45° field of view, CFP:
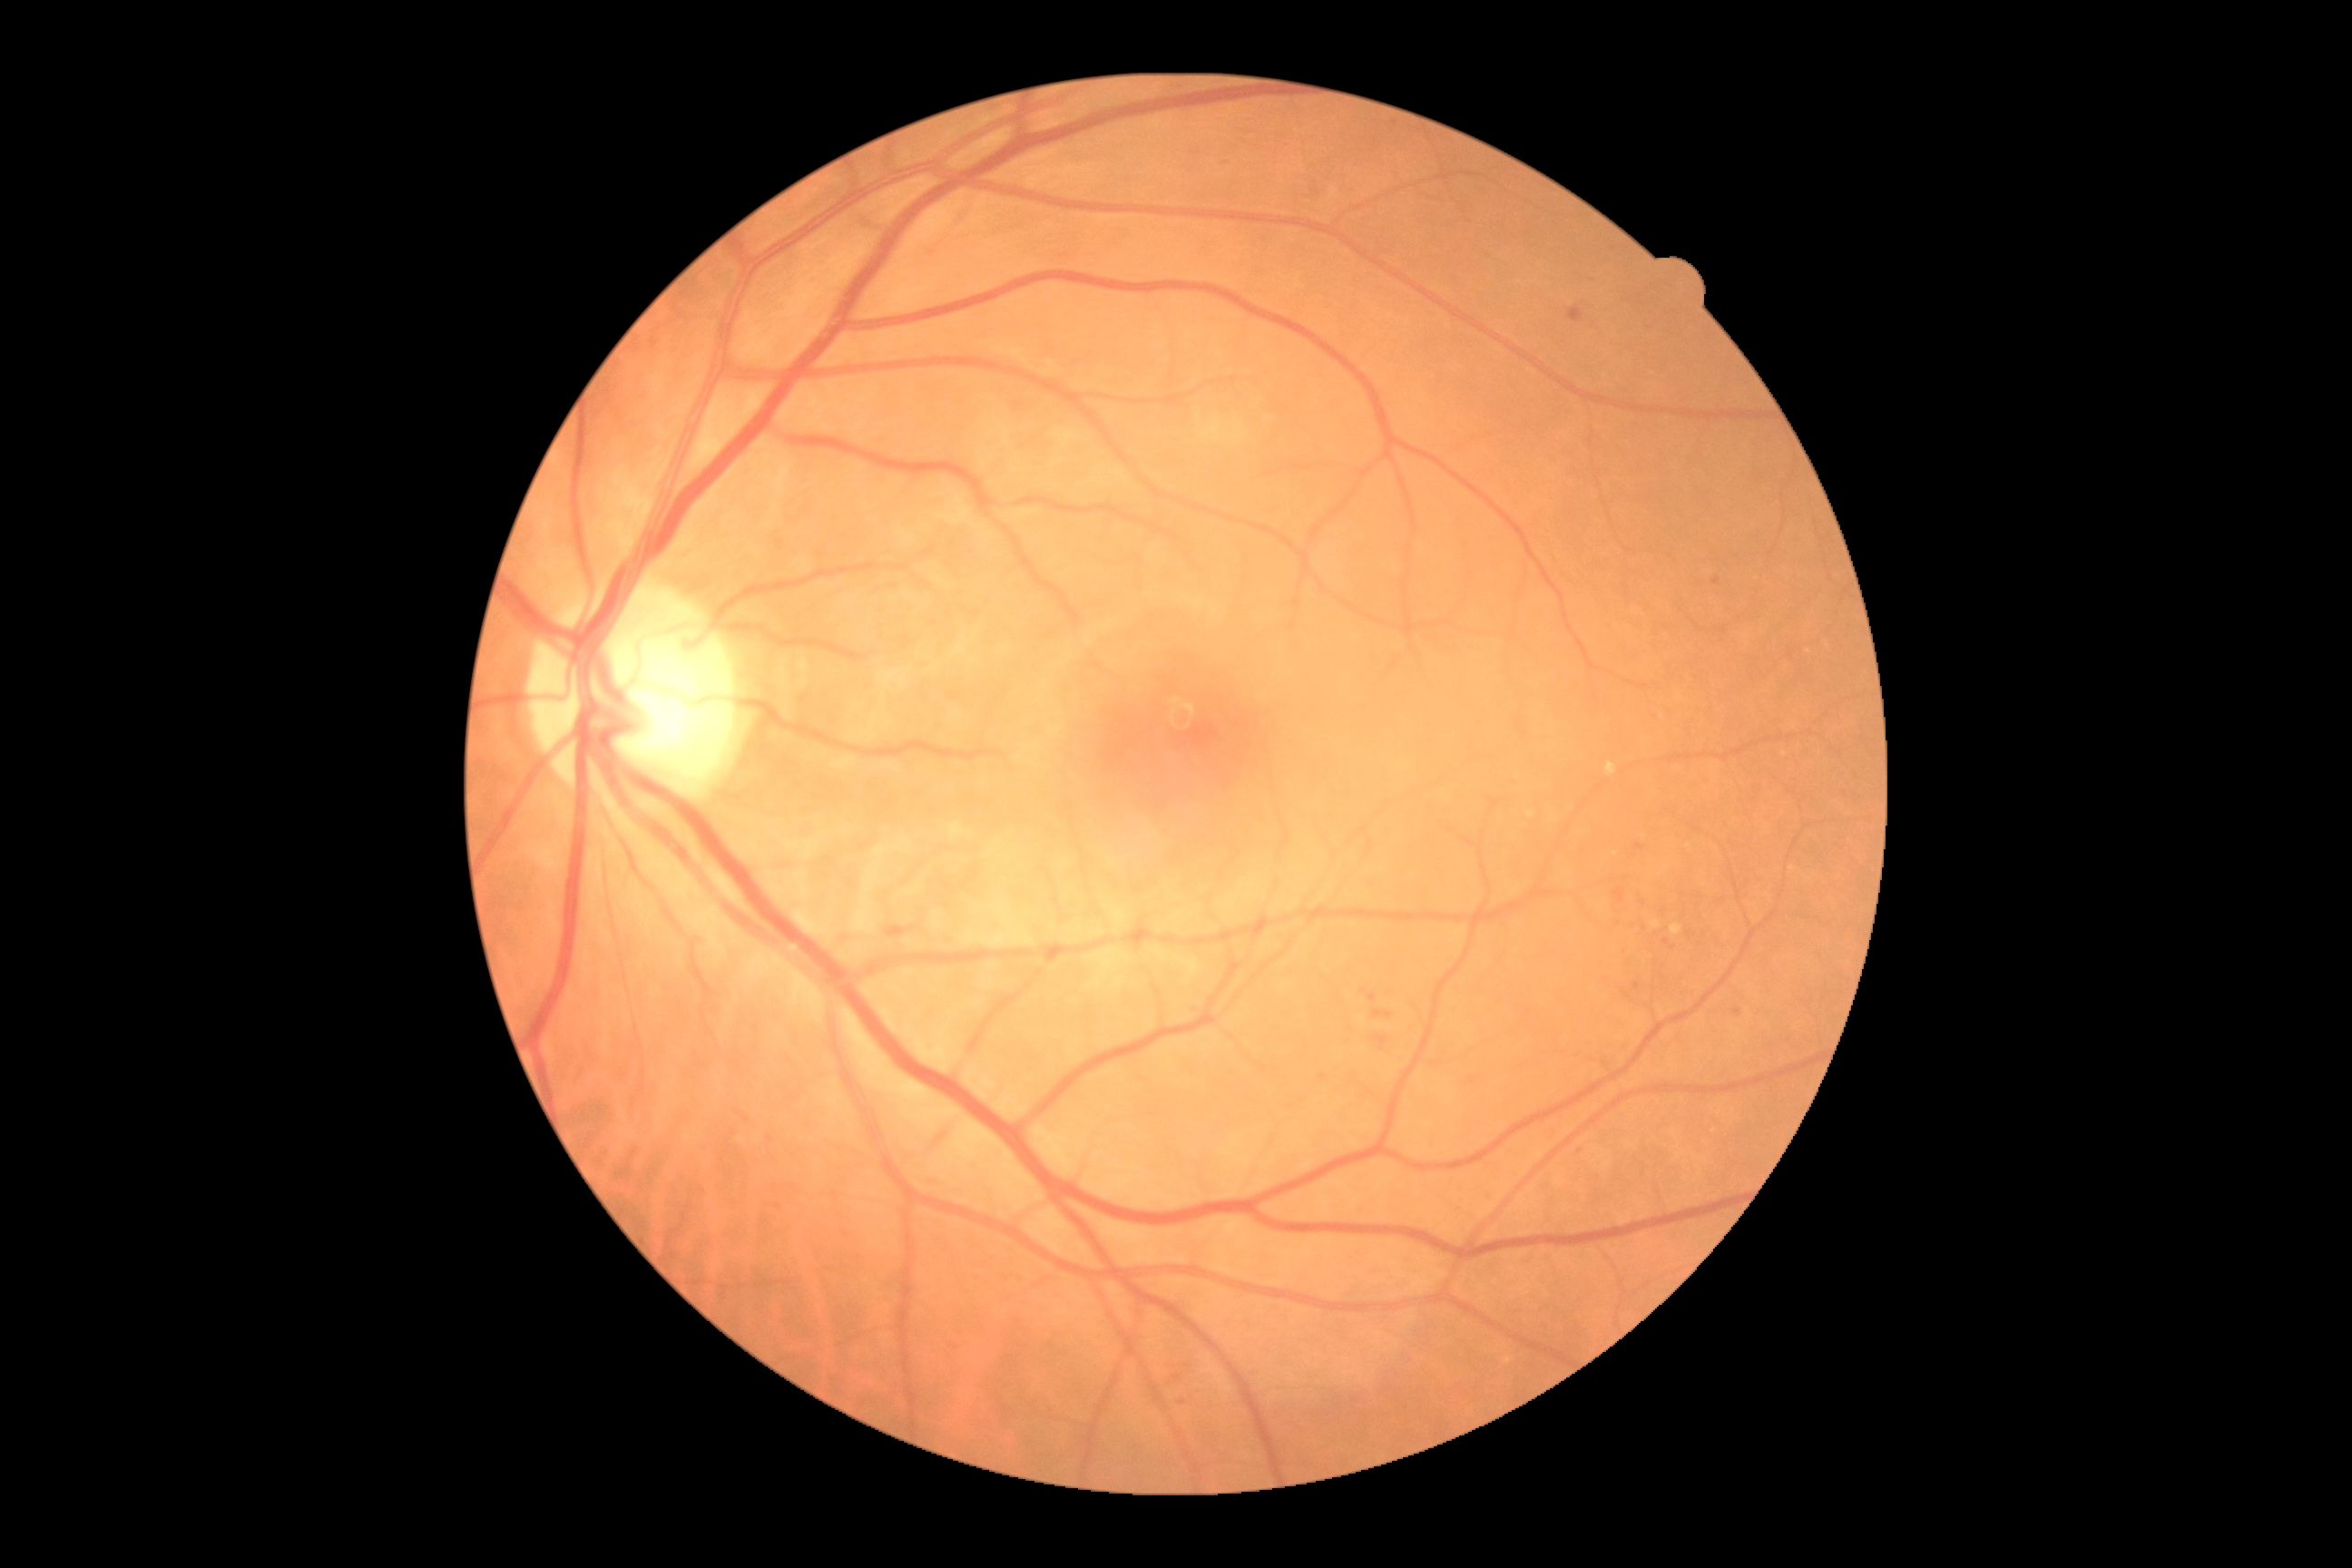

Diabetic retinopathy grade is 2 (moderate NPDR).